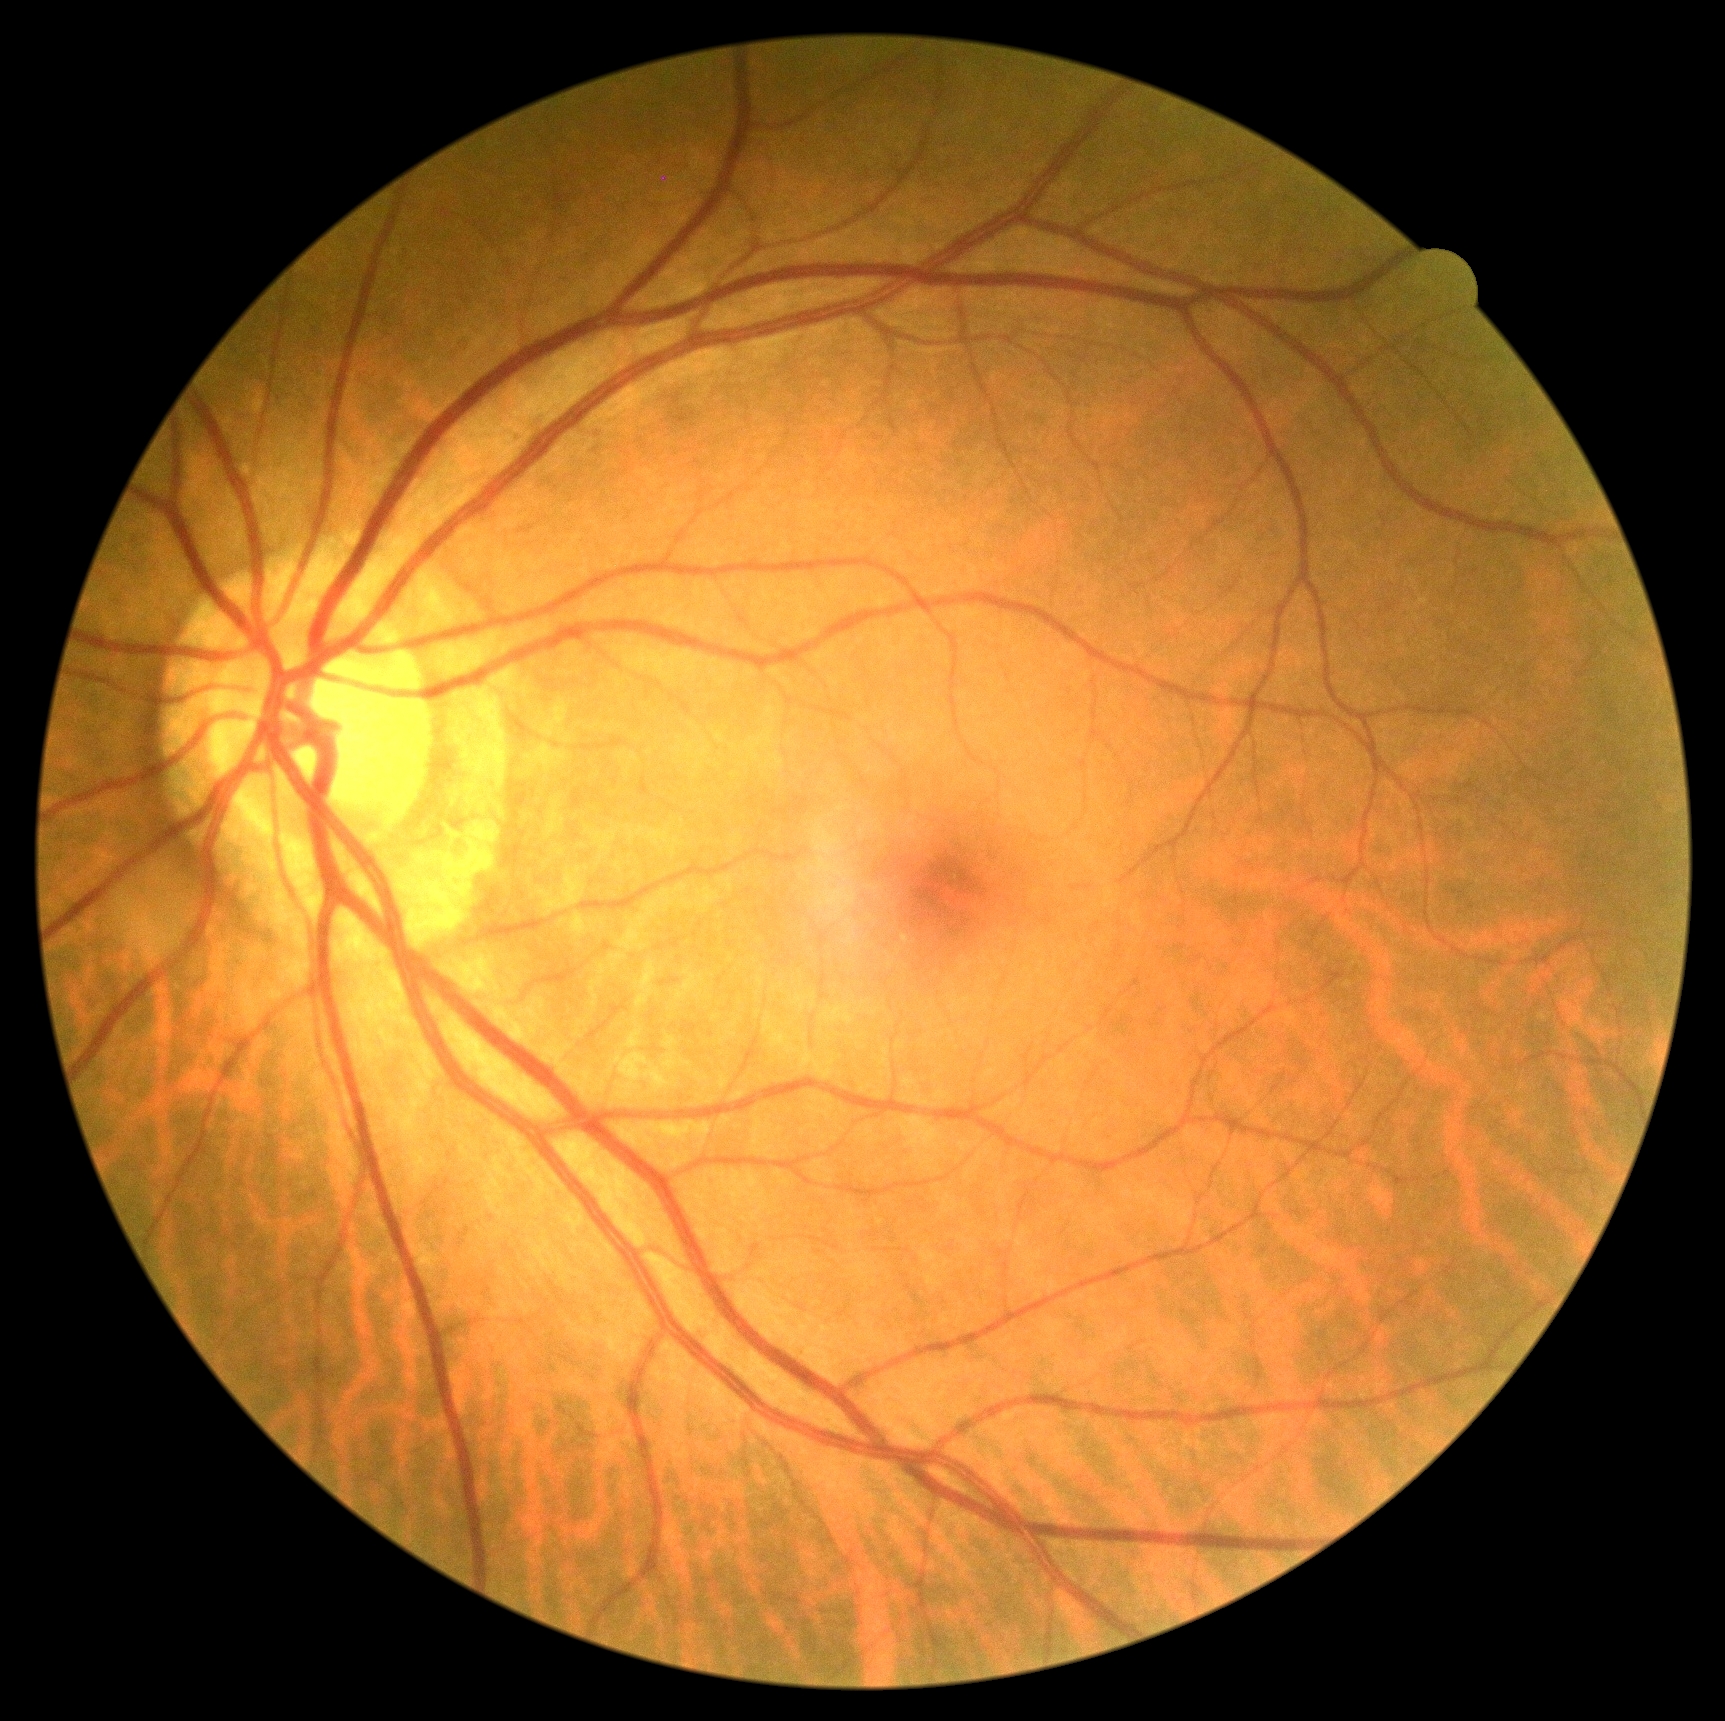 DR: 0.